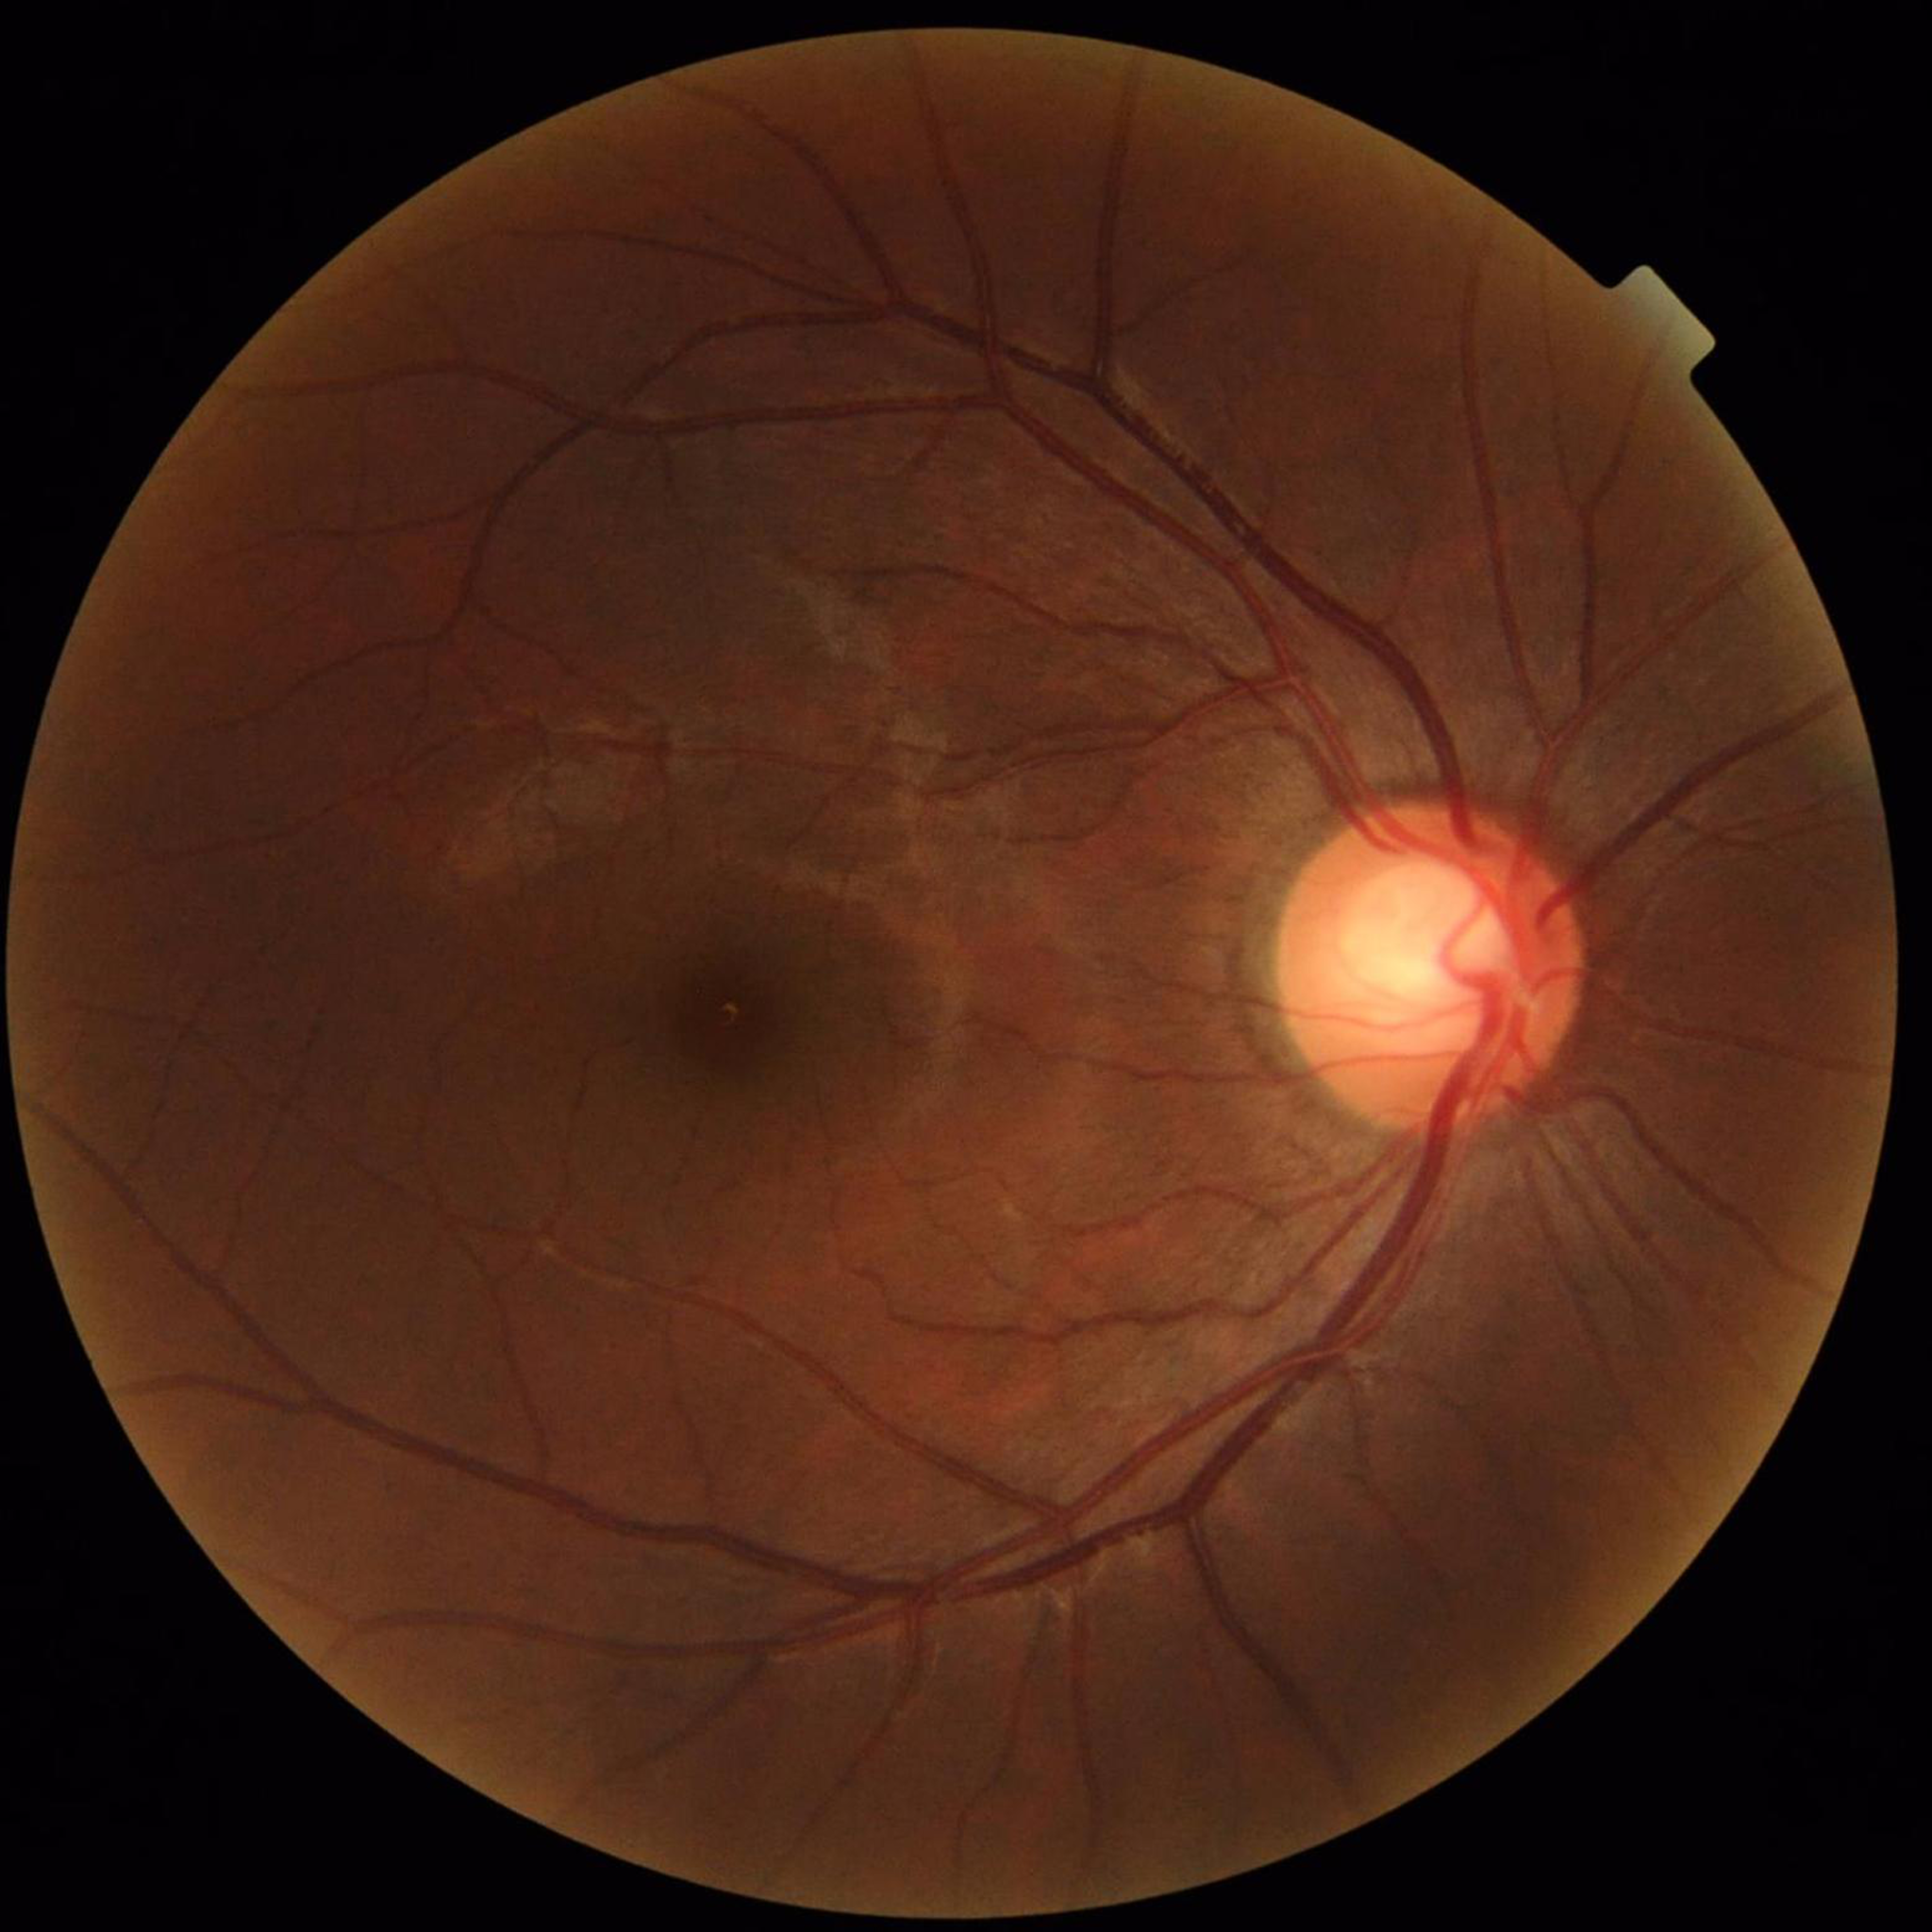

Diagnosed with glaucoma.
Photo quality: satisfactory.